2352x1568px — 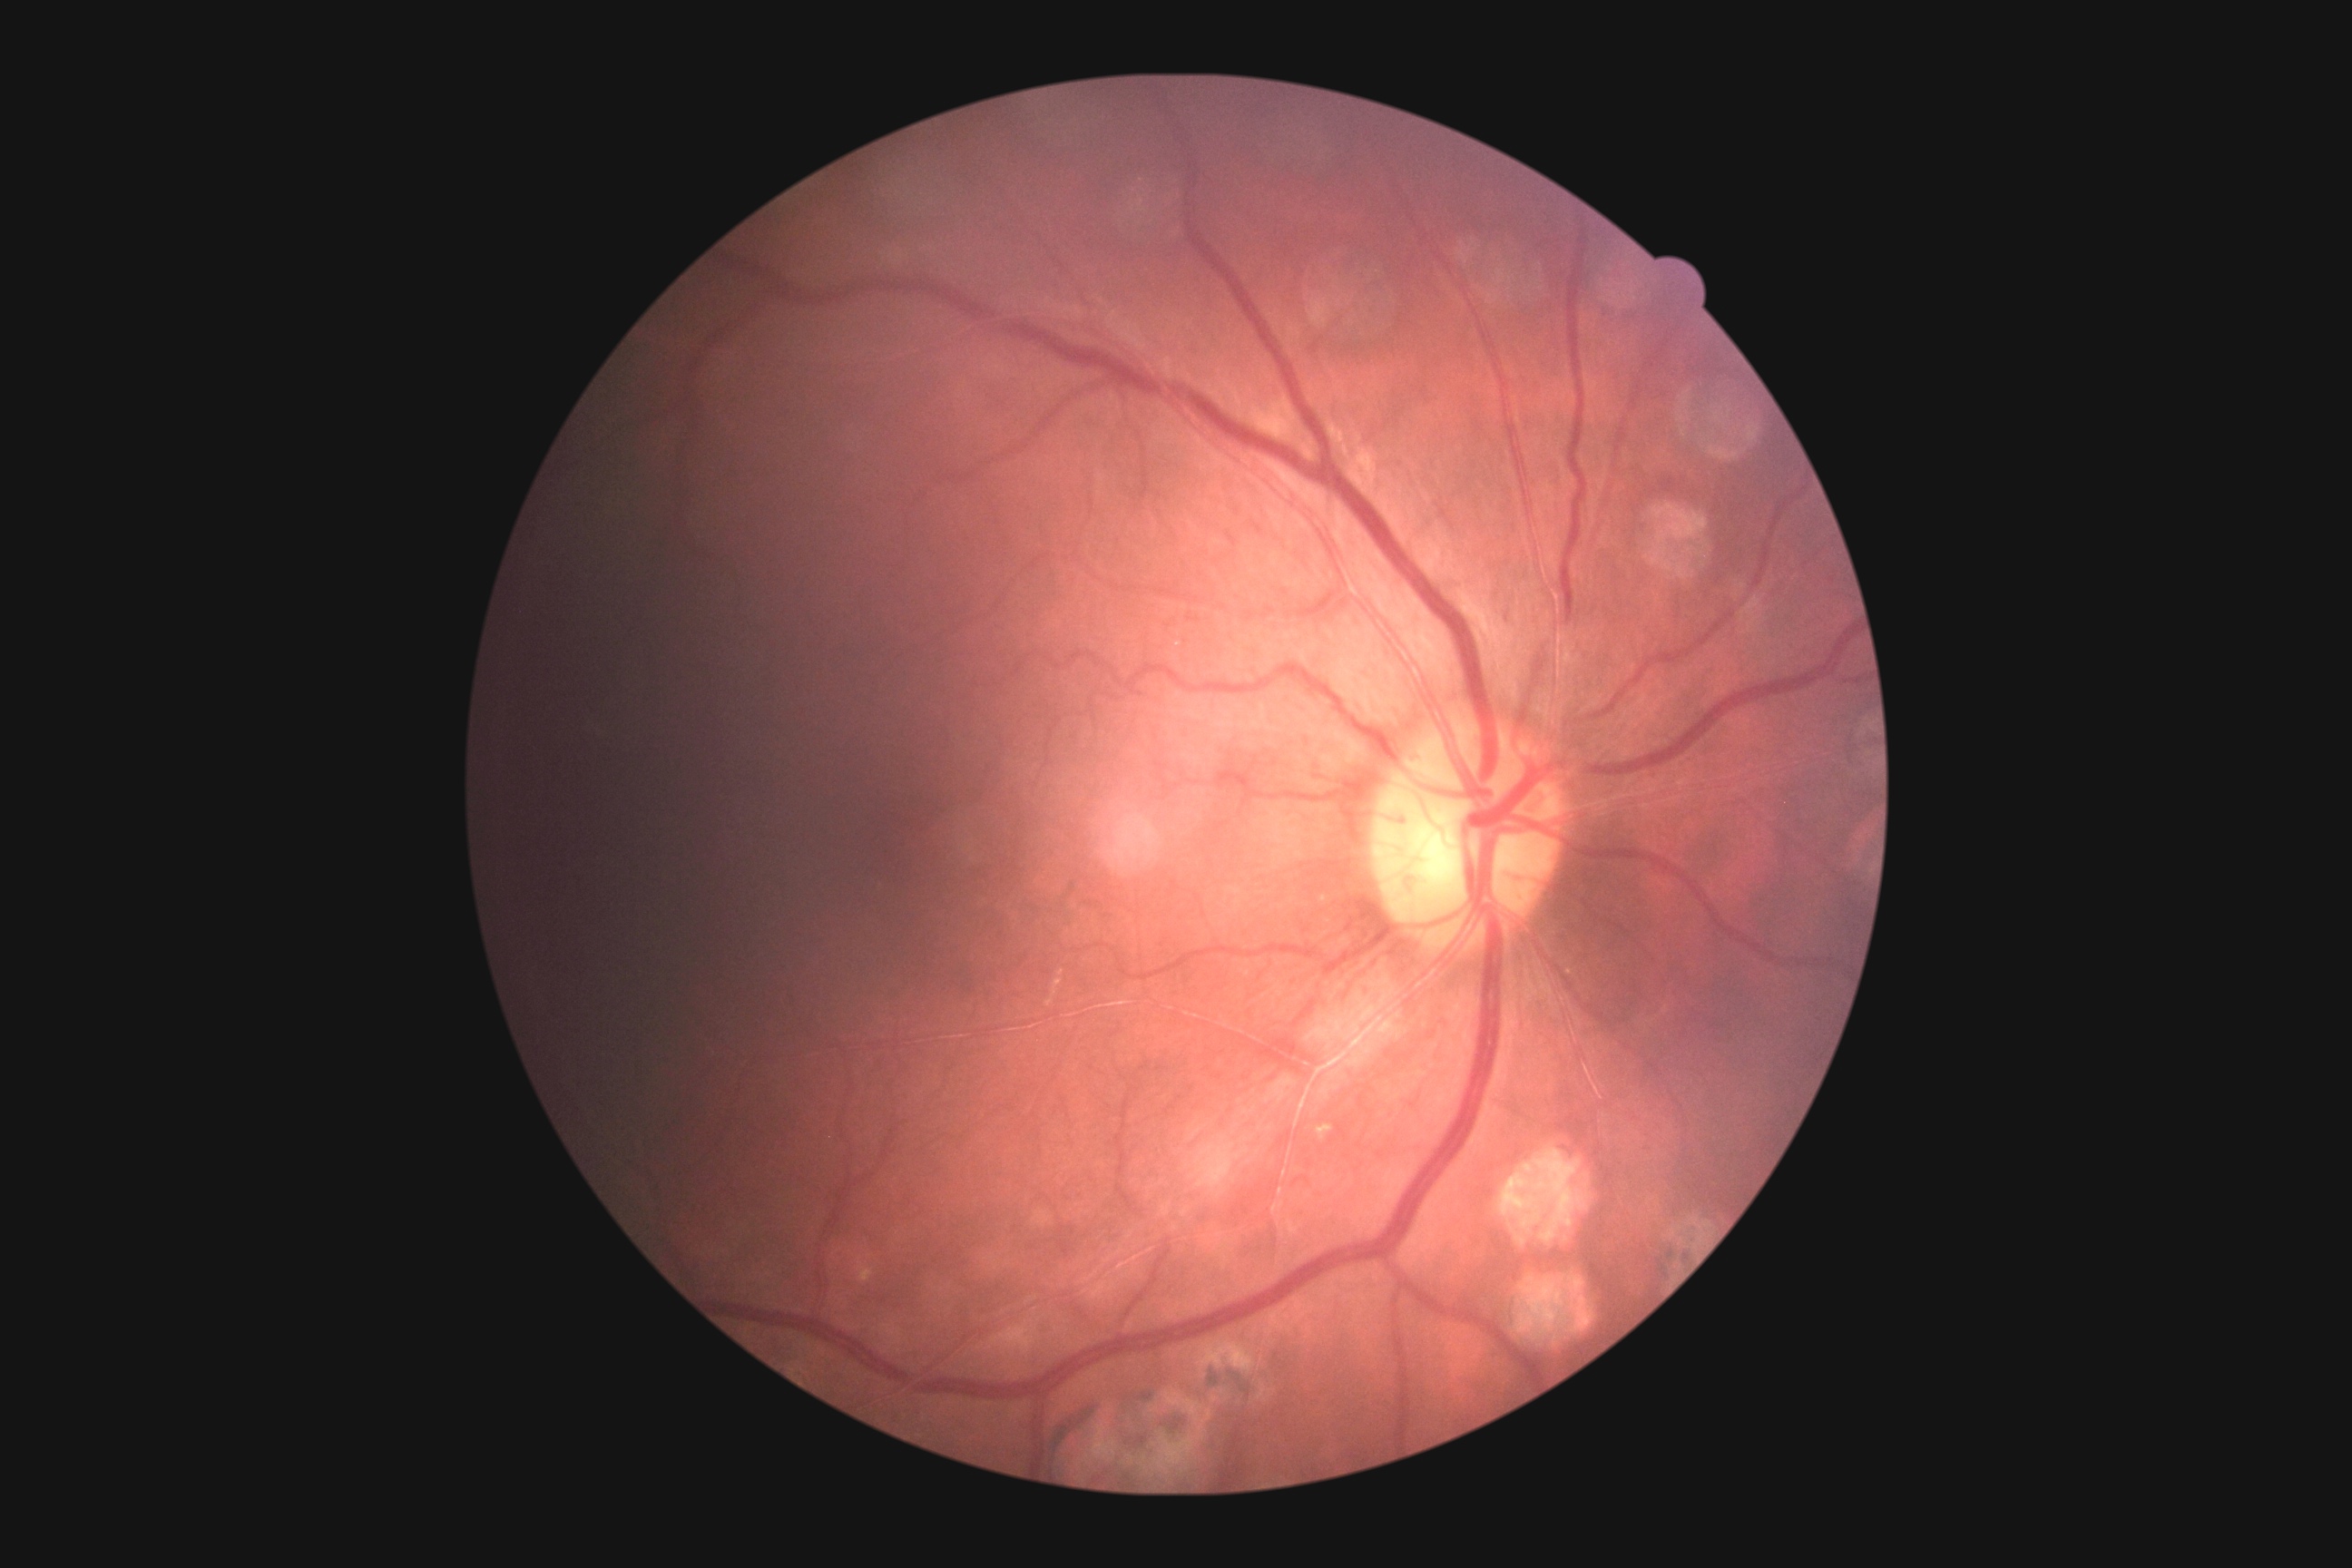
DR grade is moderate NPDR (2).